No pharmacologic dilation. Image size 848x848. 45° field of view. Retinal fundus photograph. NIDEK AFC-230.
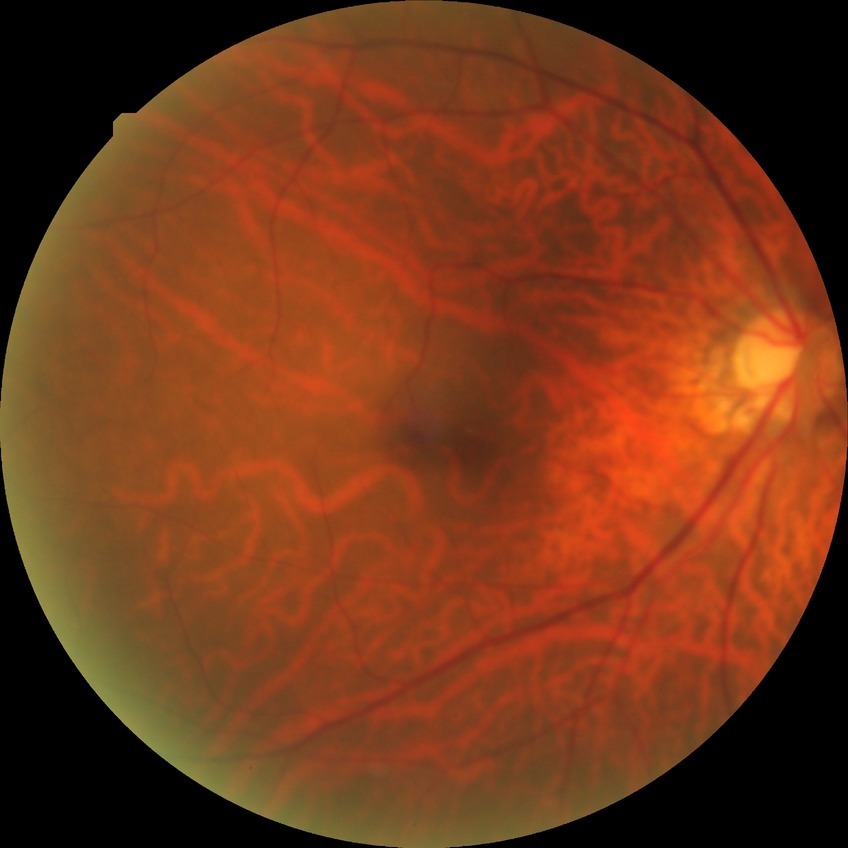

No apparent diabetic retinopathy. DR: NDR.